Posterior pole color fundus photograph
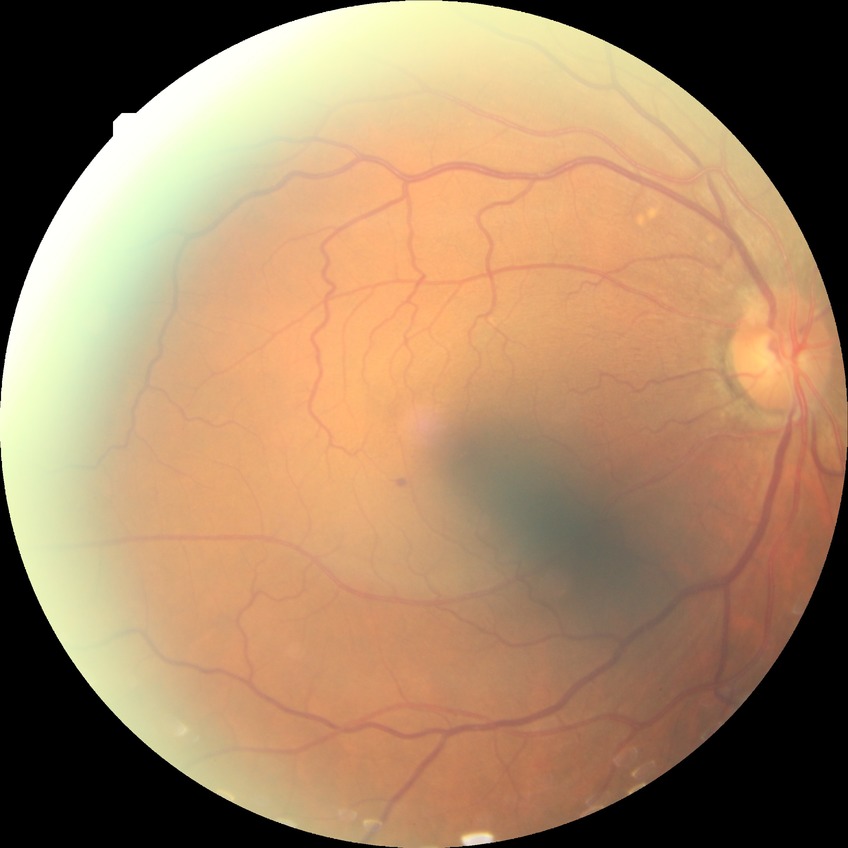 Diabetic retinopathy (DR): simple diabetic retinopathy (SDR).